Posterior pole view; 2228 x 1652 pixels; color fundus image; FOV: 50 degrees.
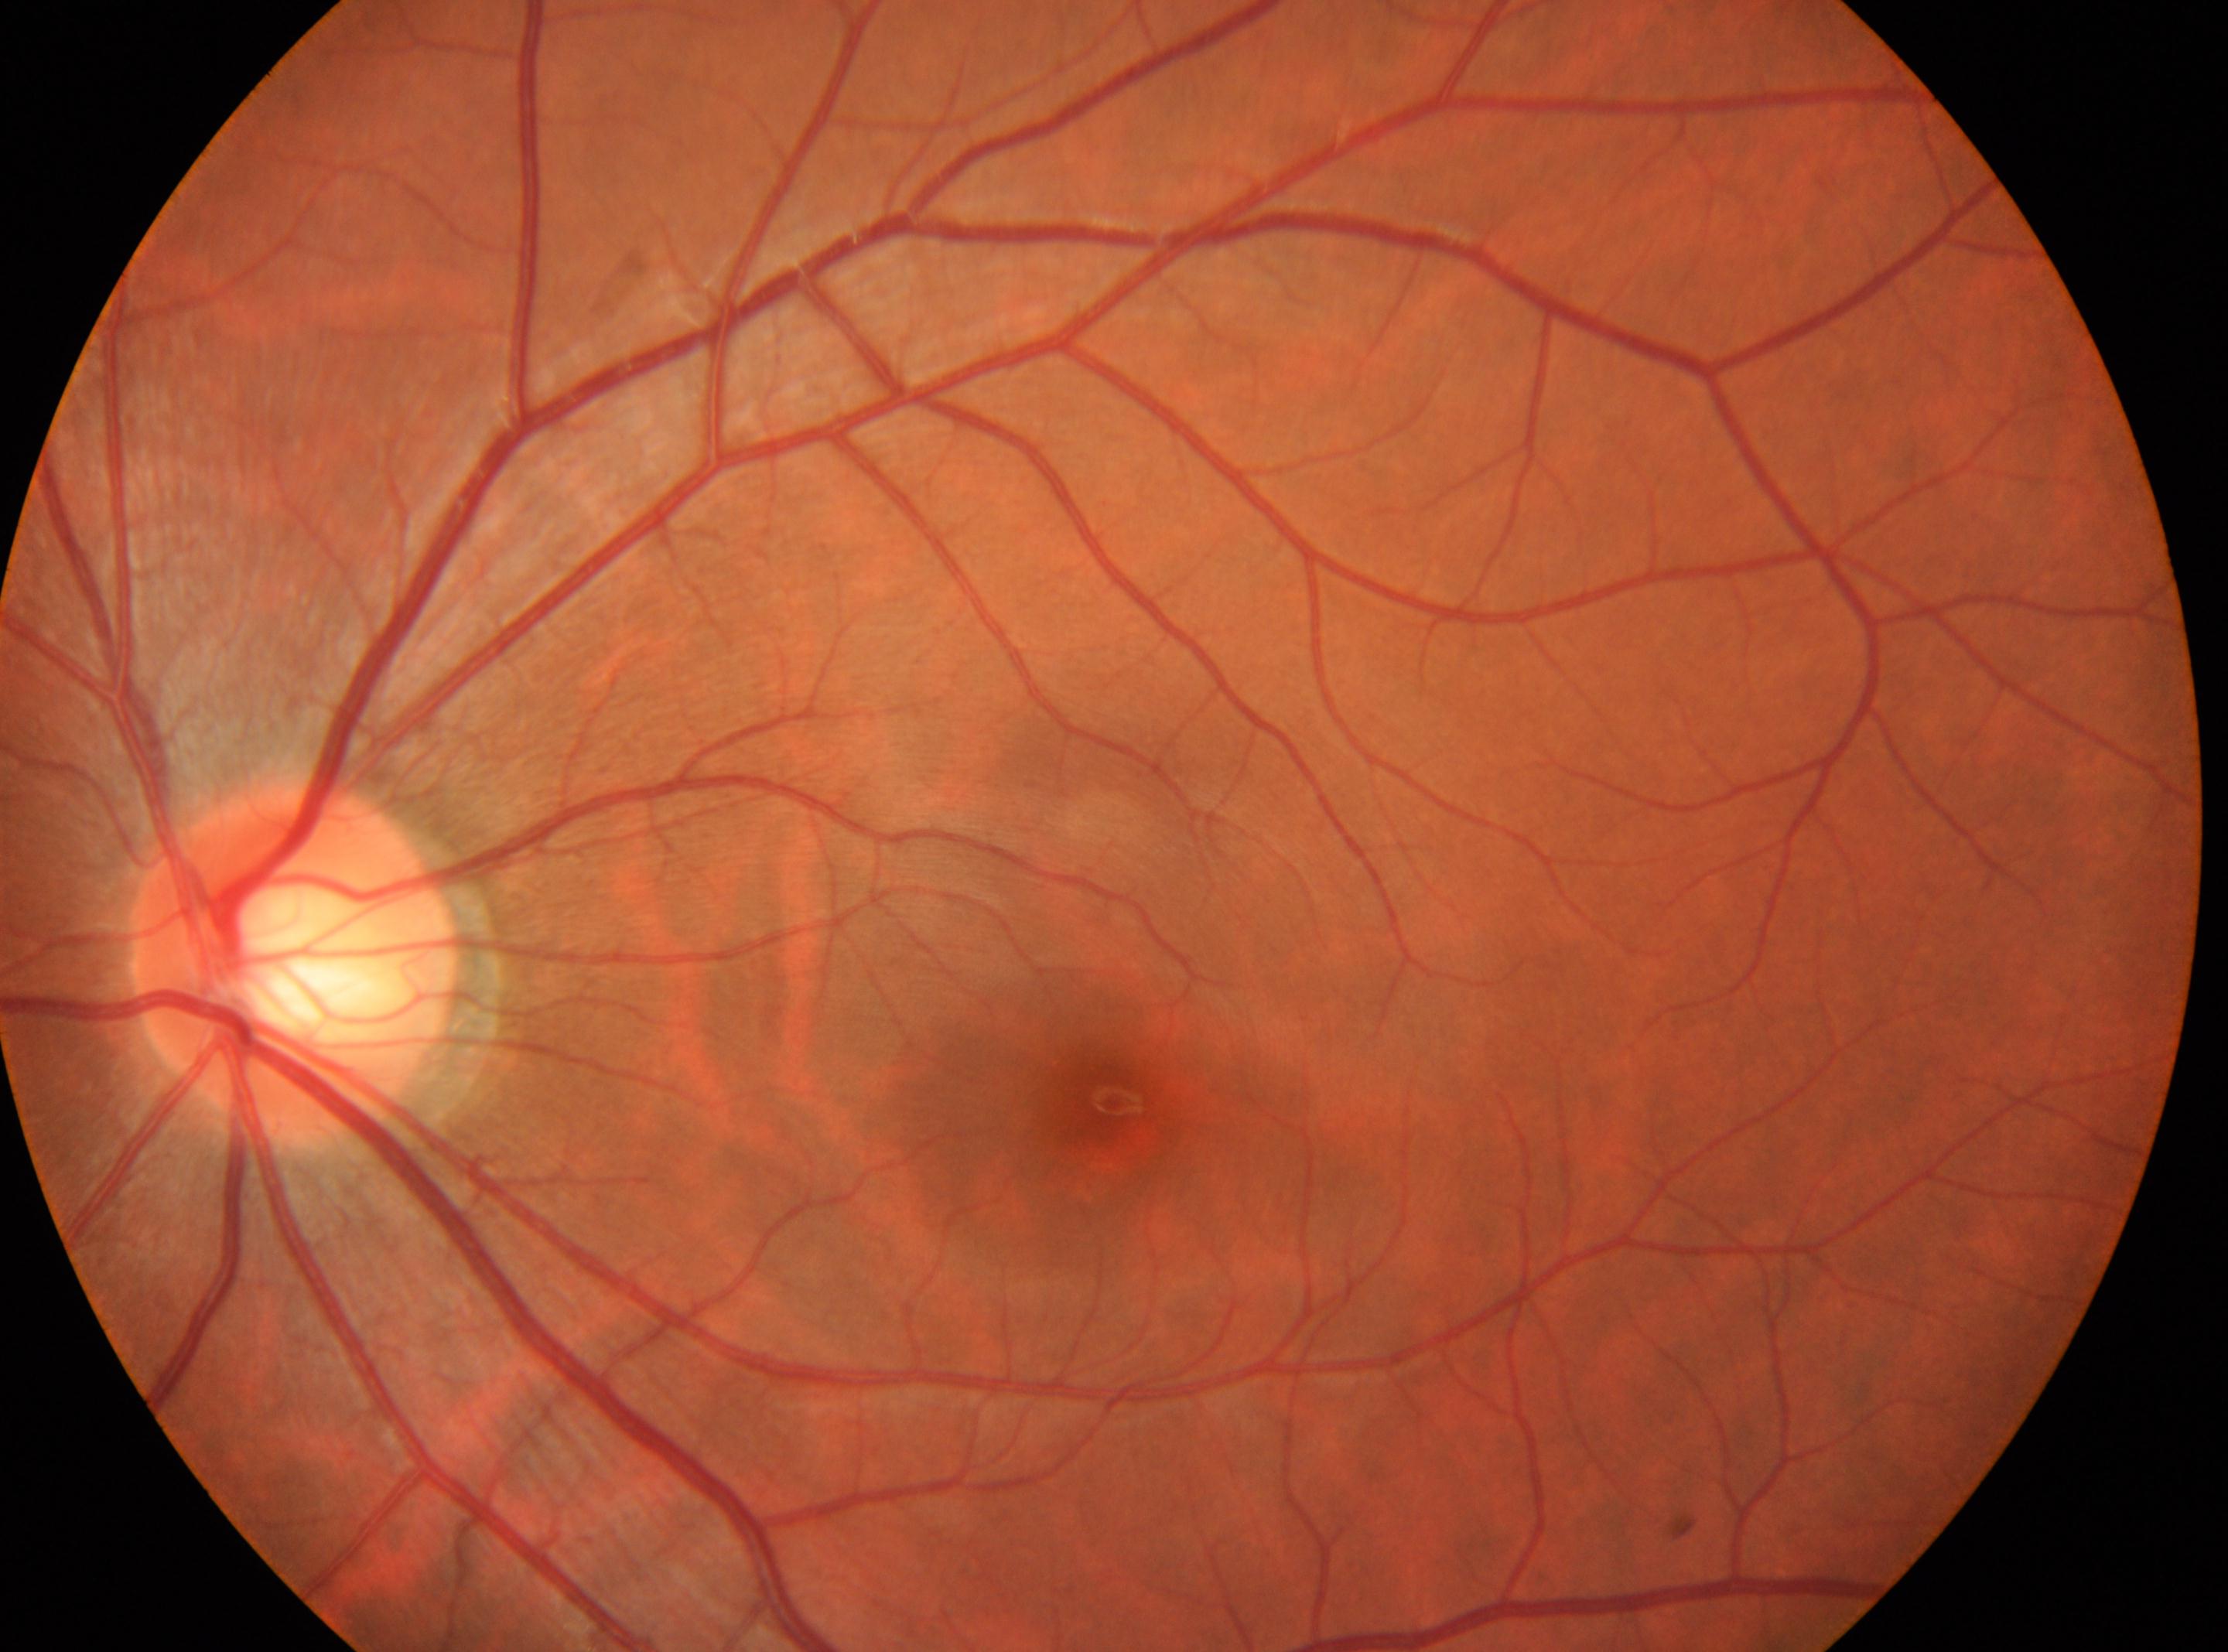
Q: Where is the fovea?
A: 1109, 1101
Q: DR stage?
A: no apparent retinopathy (grade 0) — no visible signs of diabetic retinopathy
Q: What is the laterality?
A: oculus sinister
Q: Optic disc center?
A: 294, 962